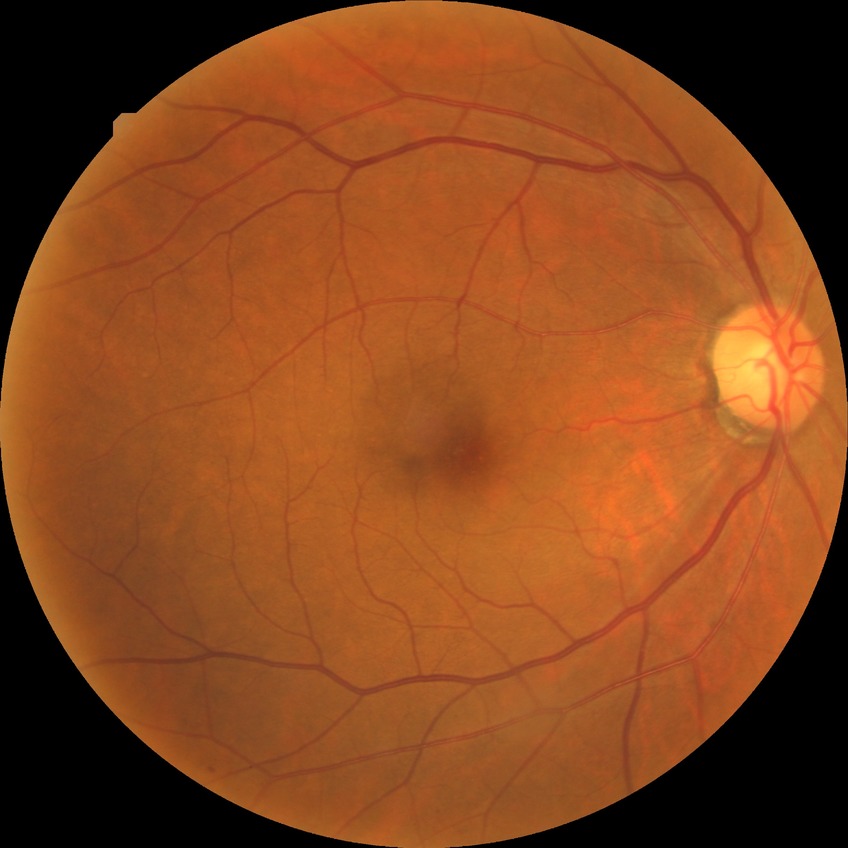 Diabetic retinopathy (DR): simple diabetic retinopathy (SDR).